Wide-field fundus image from infant ROP screening:
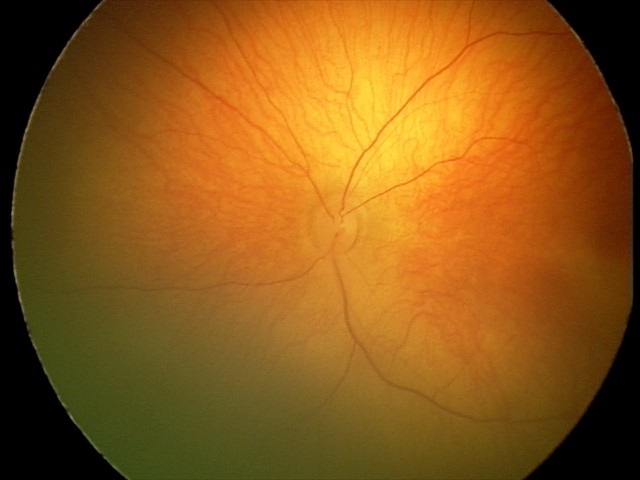

Examination diagnosed as retinal hemorrhages.